2352x1568px.
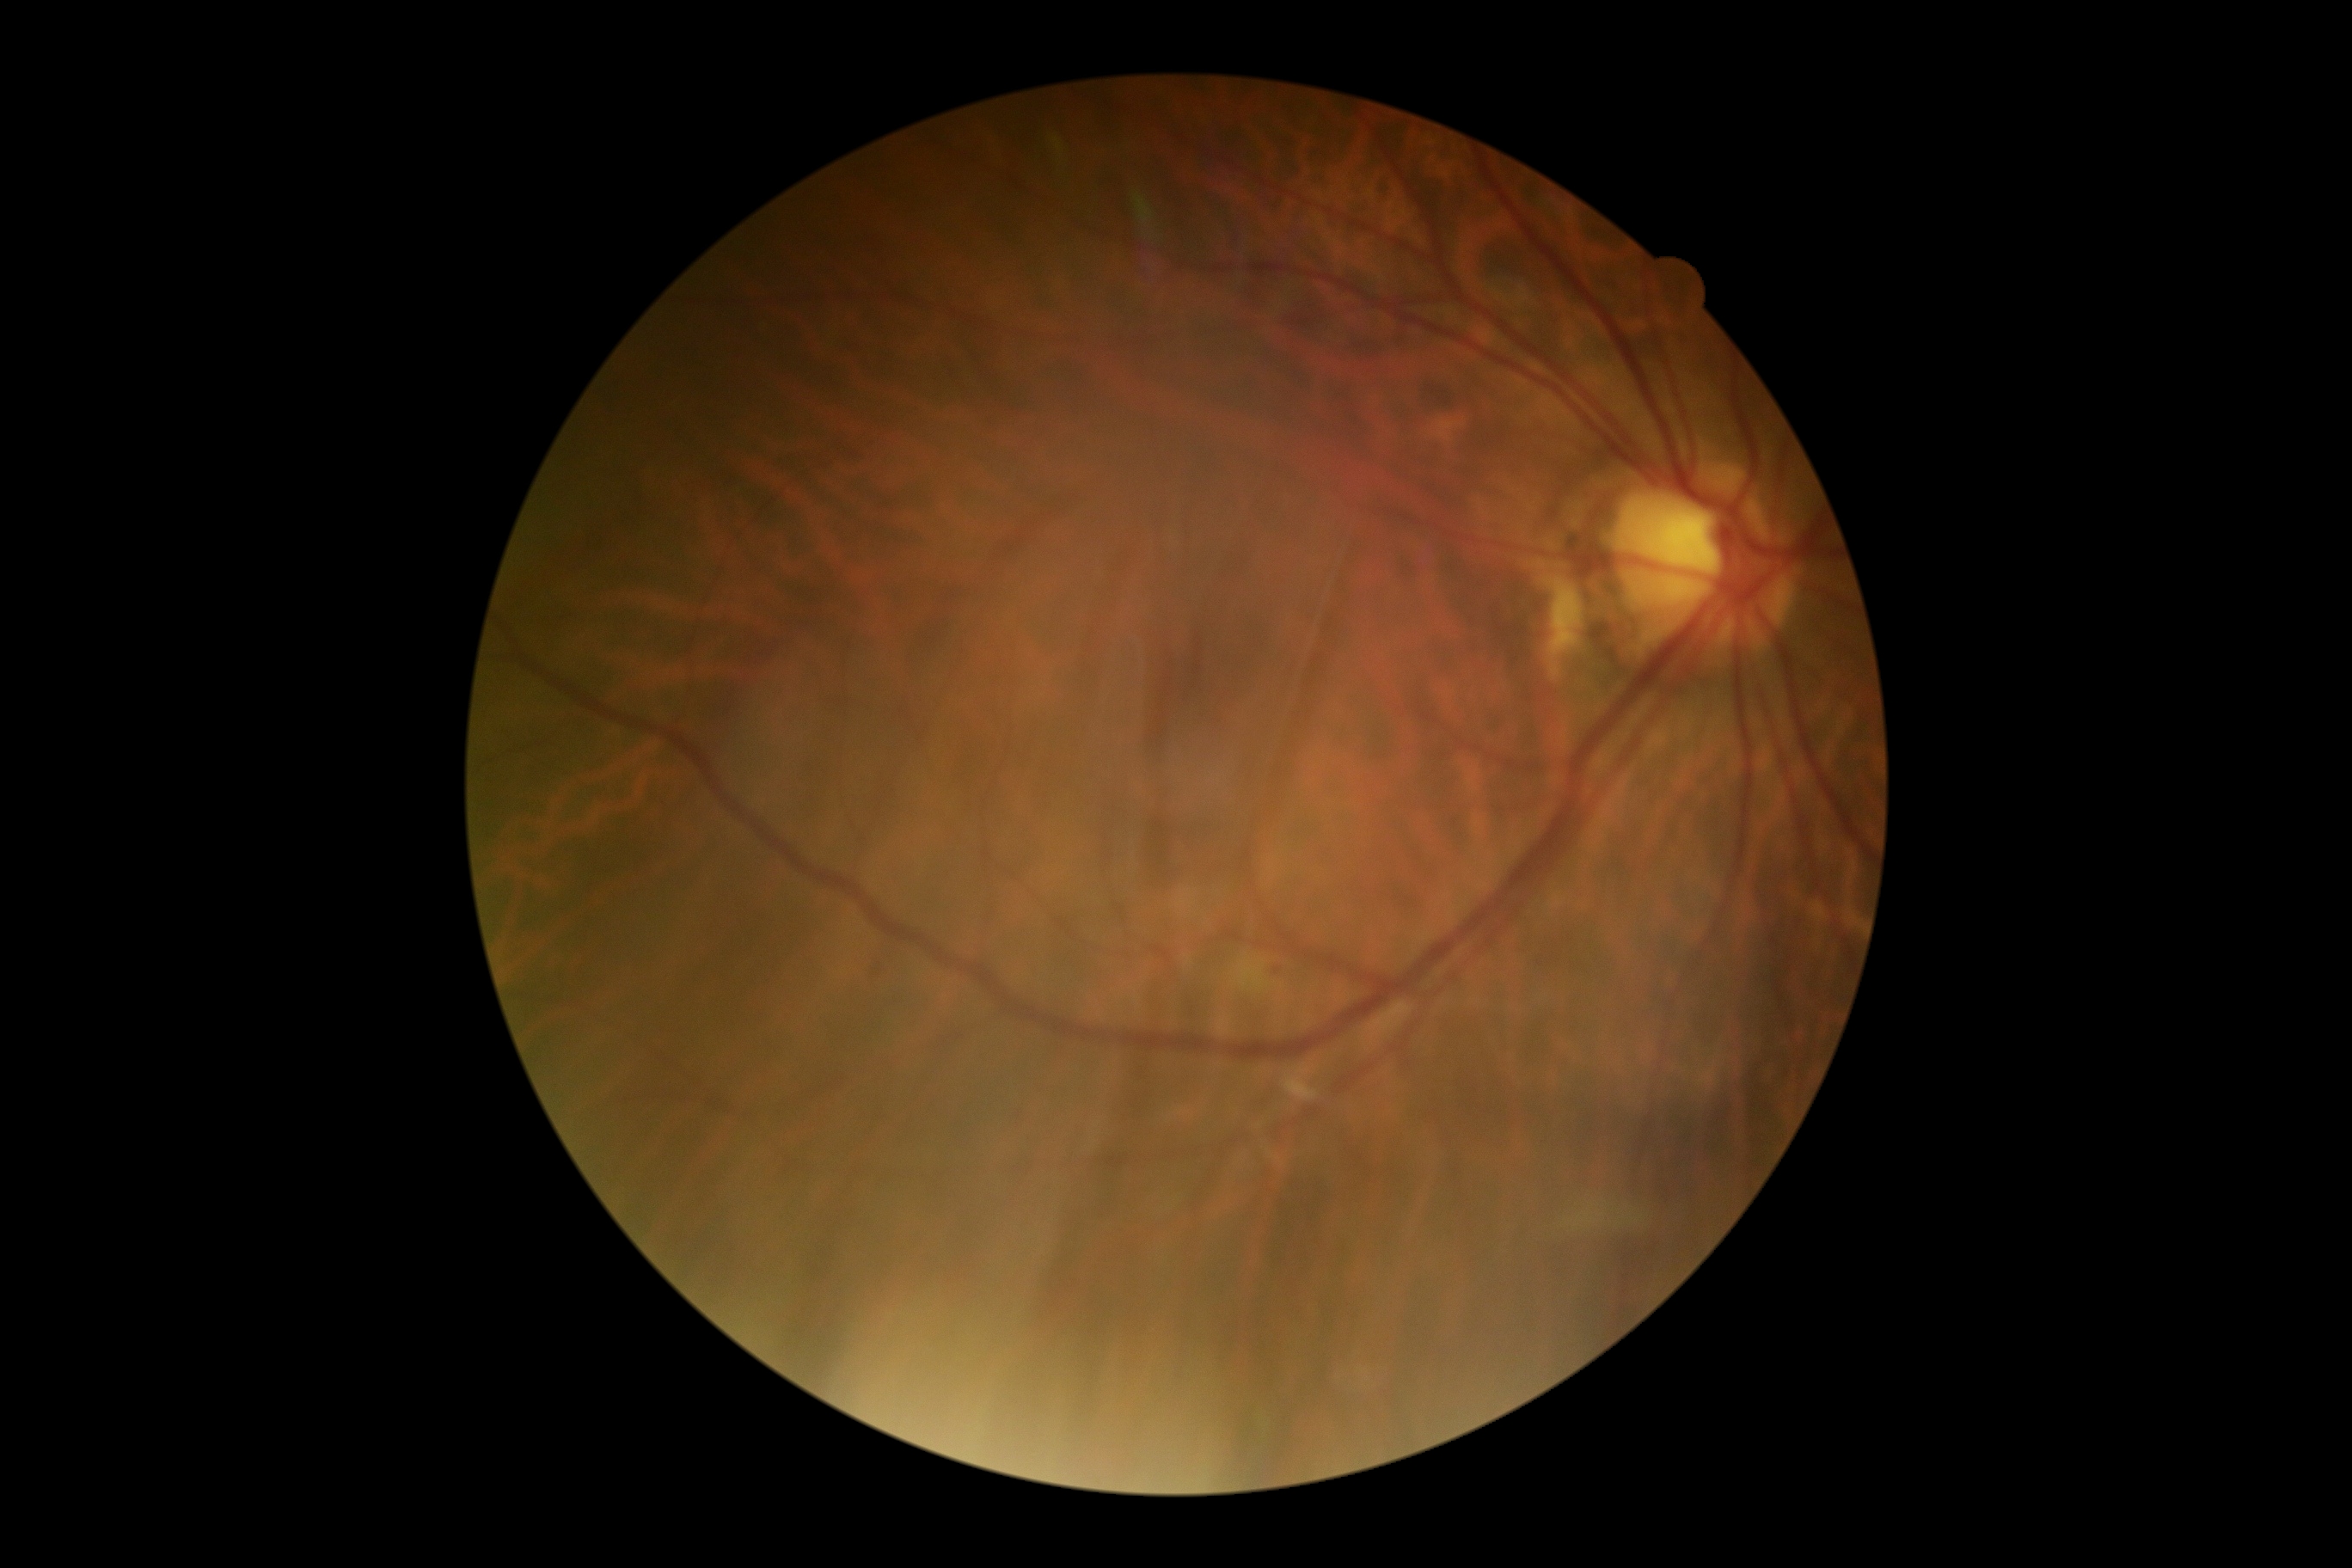

DR stage: 2/4.